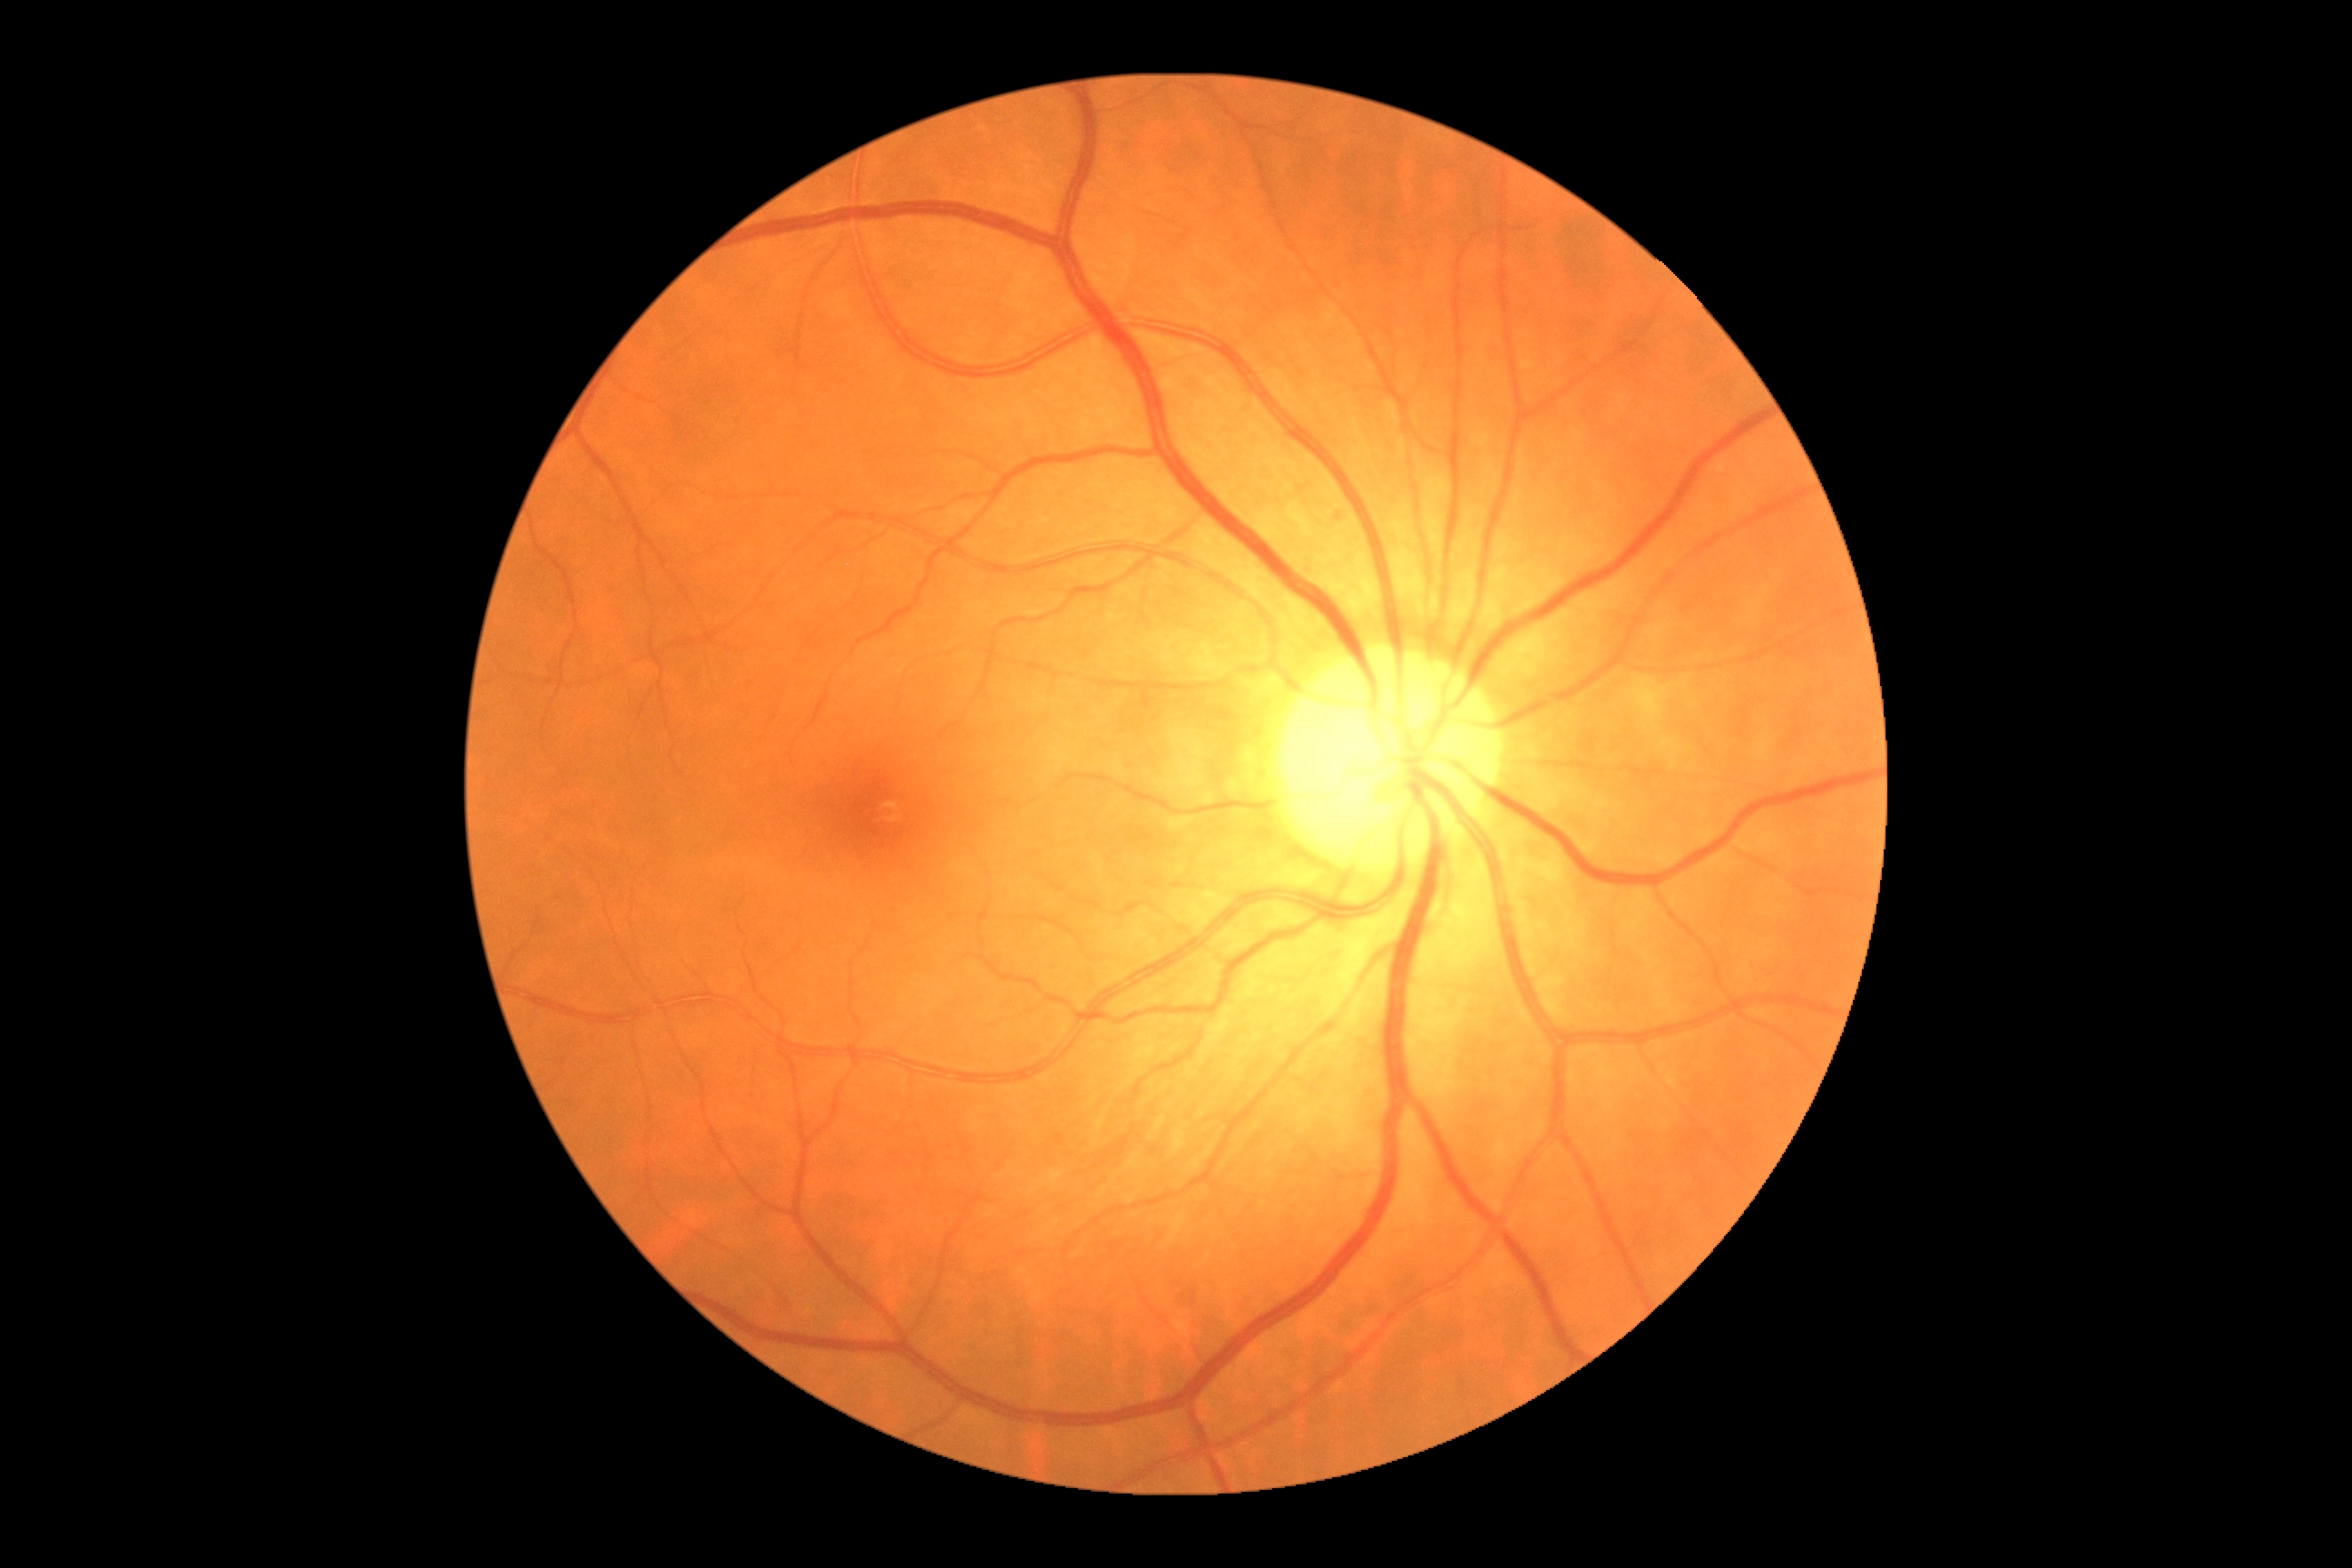
DR is grade 0.